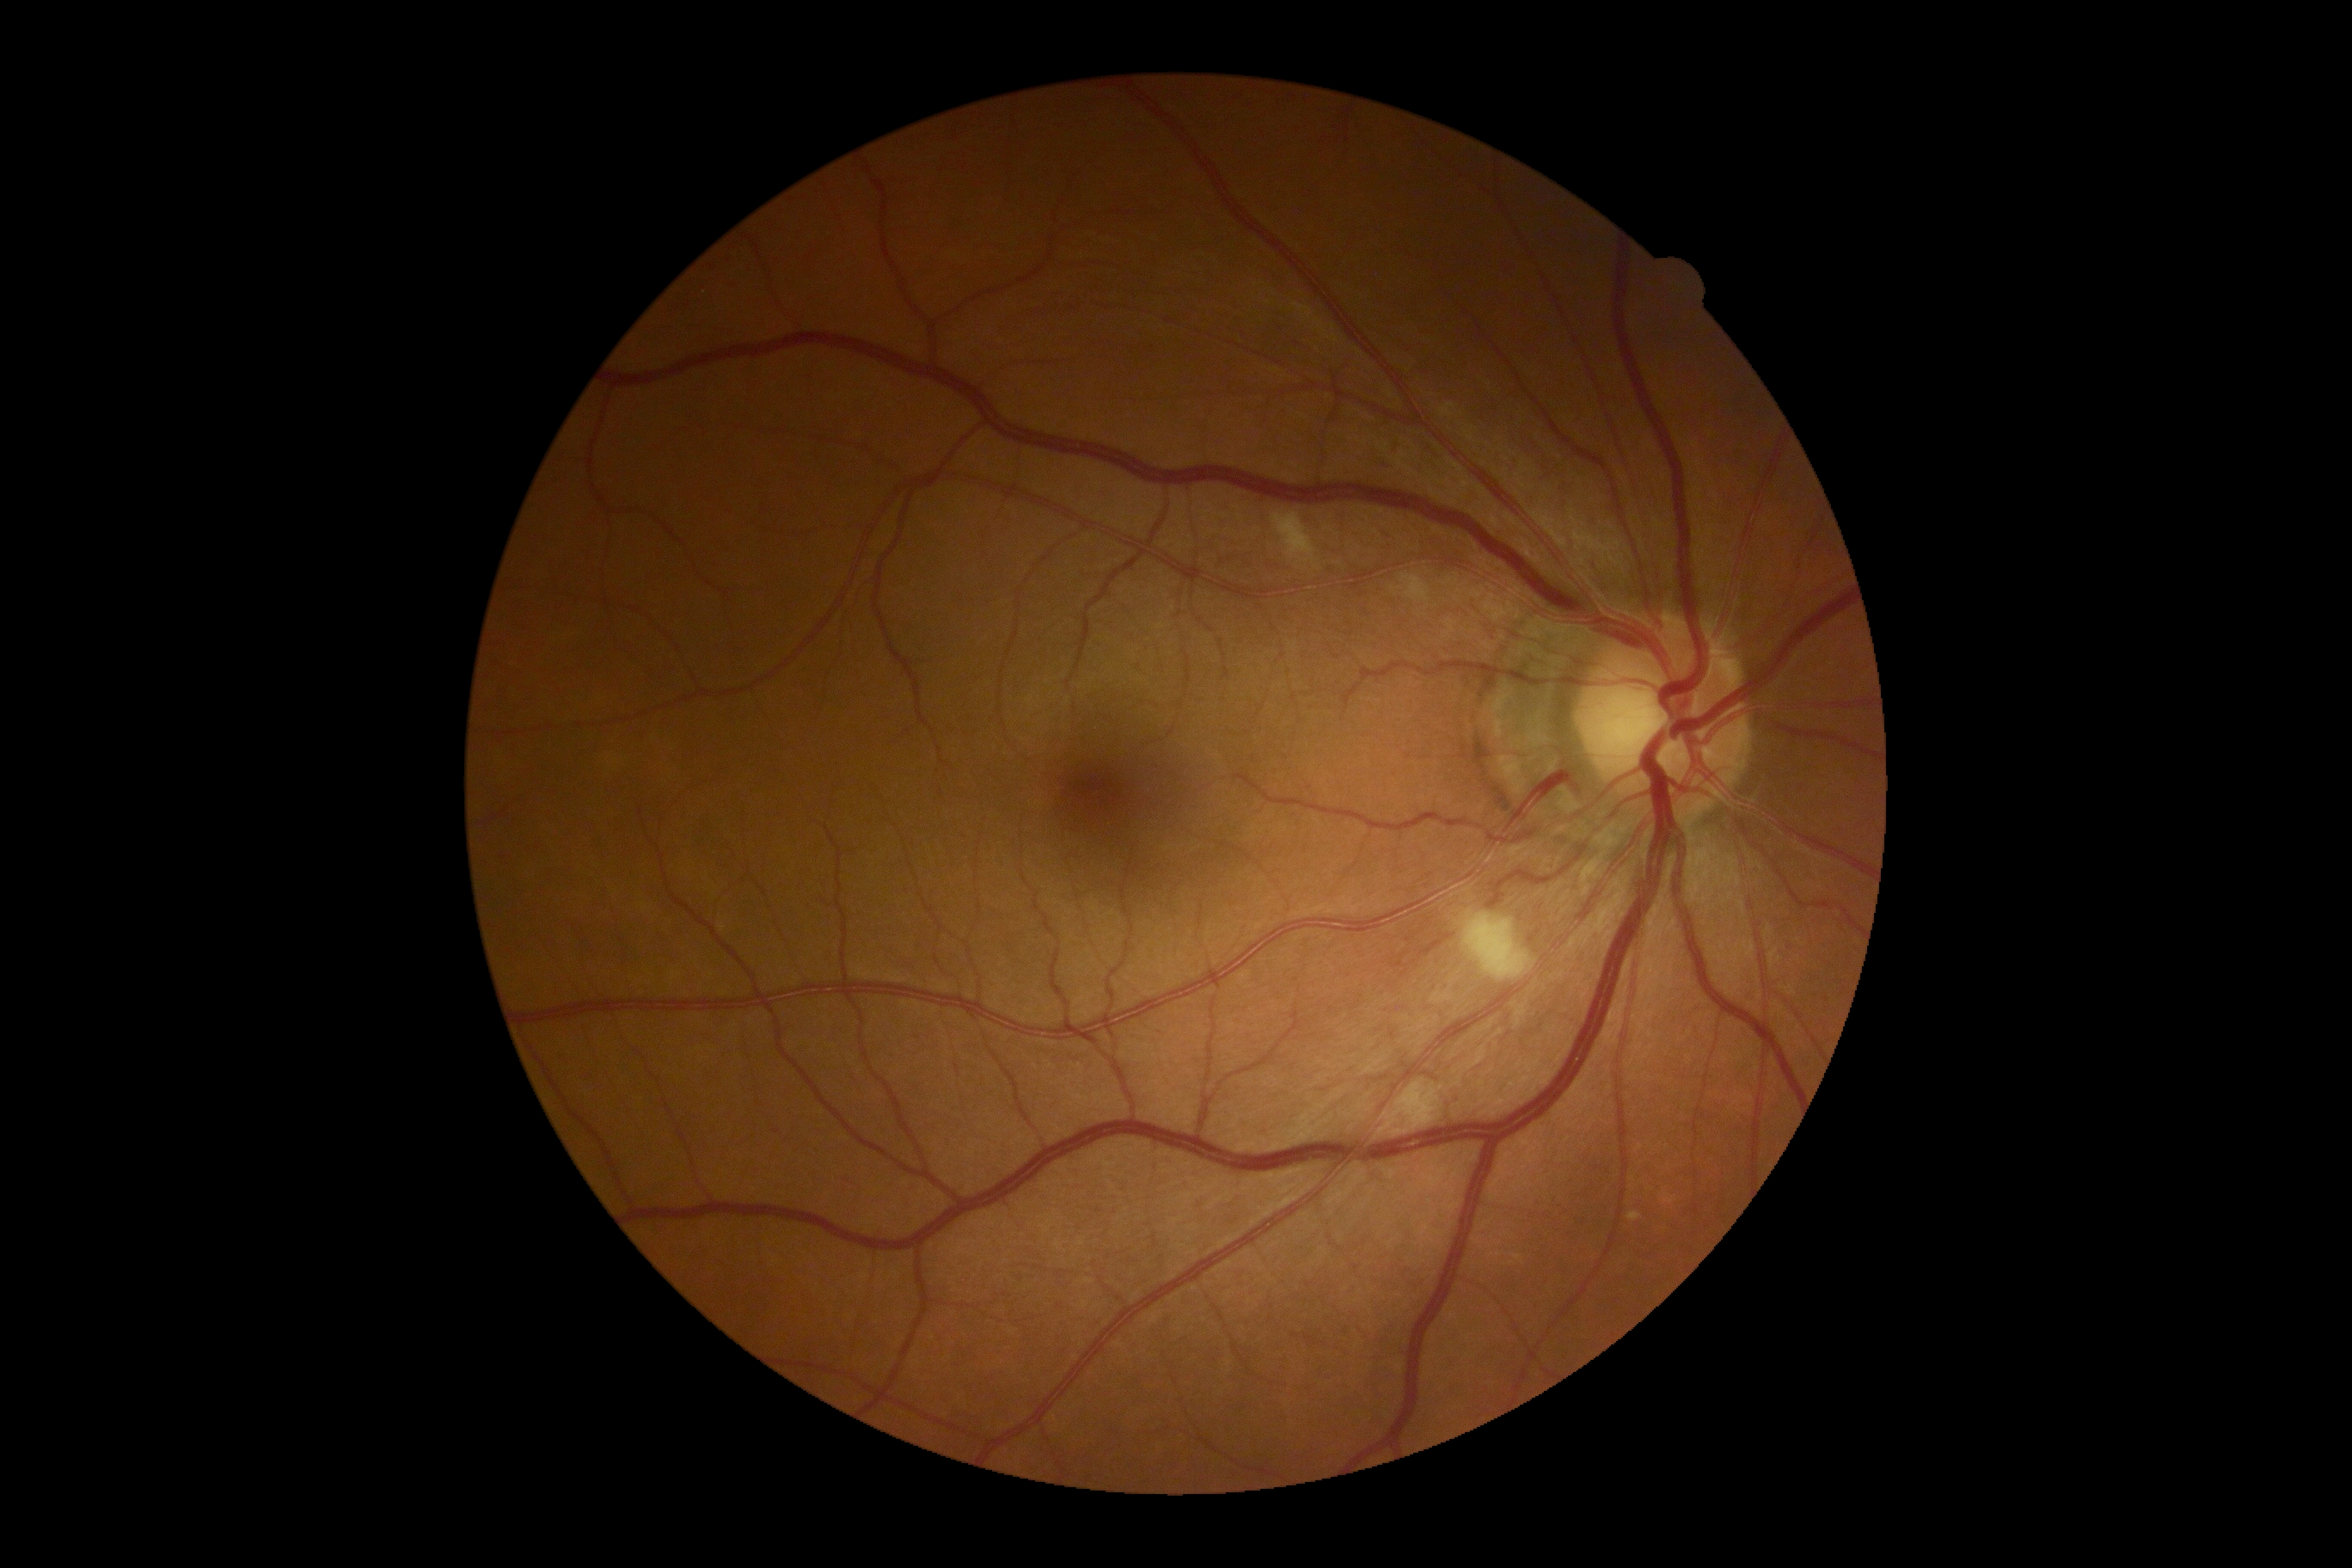 DR stage: 2/4.